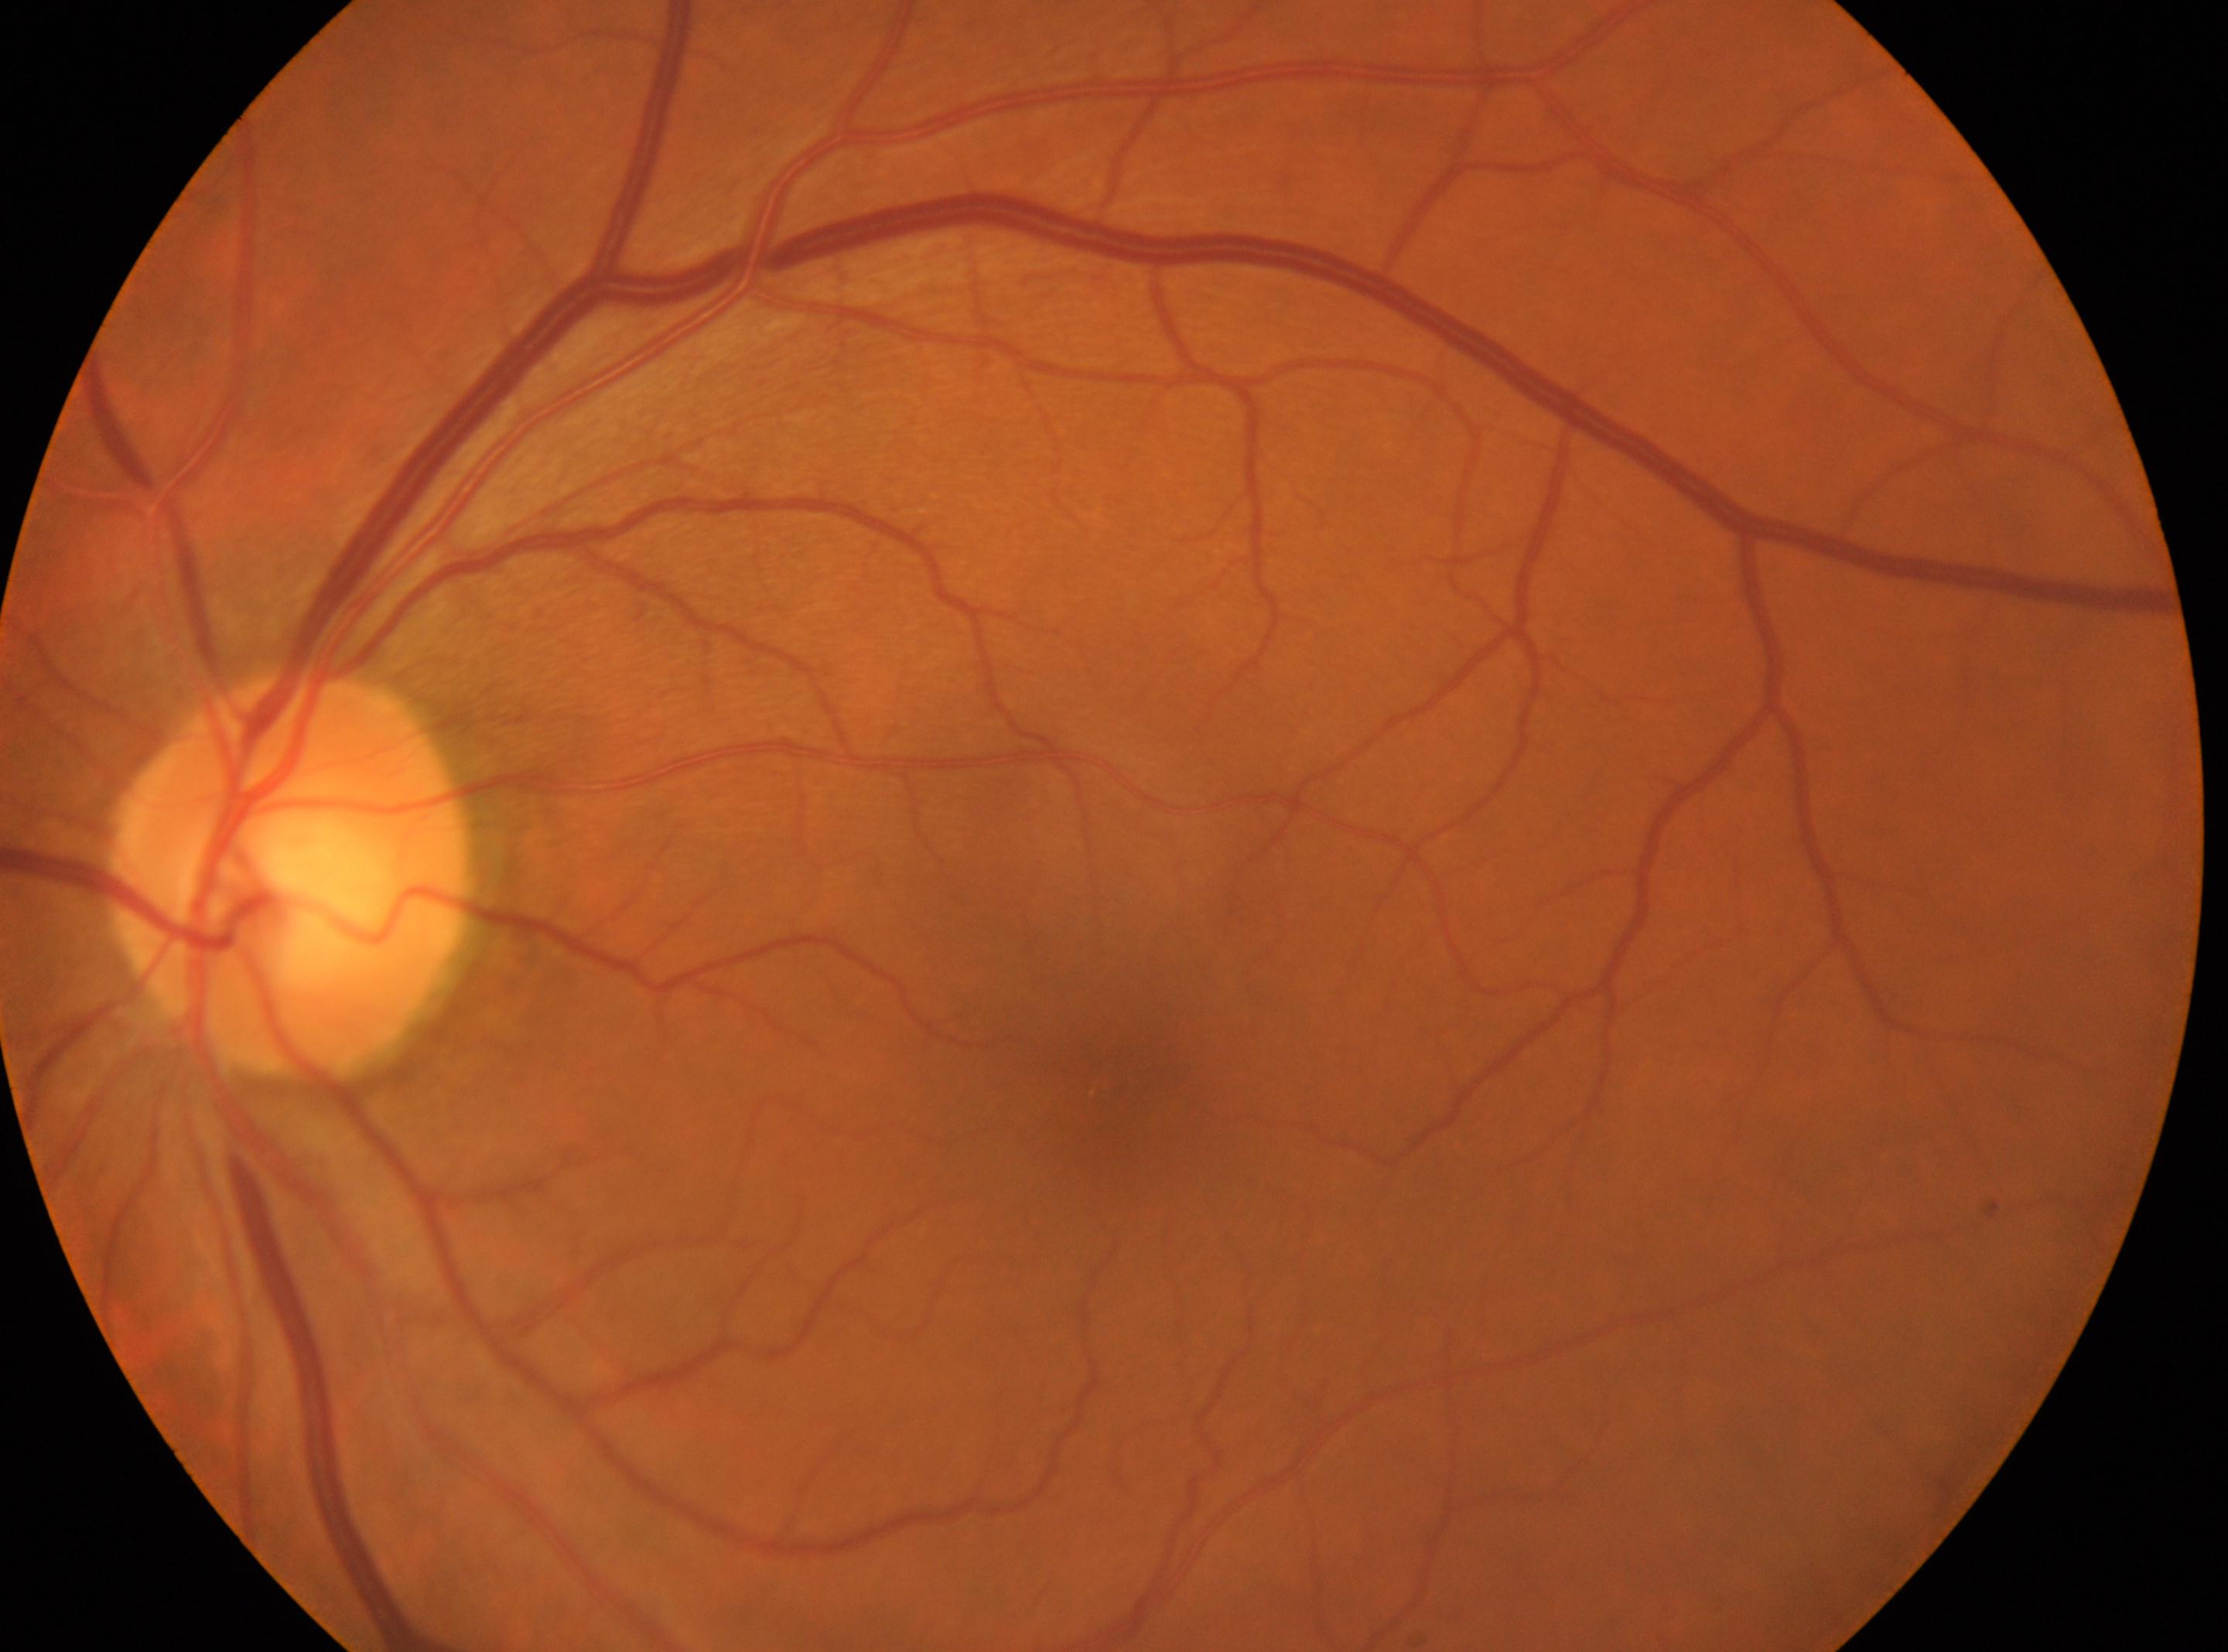 Eye: left.
Optic nerve head located at (287, 875).
DR stage is grade 0 (no apparent retinopathy).
Fovea located at (1126, 1070).